CFP. Non-mydriatic fundus camera.
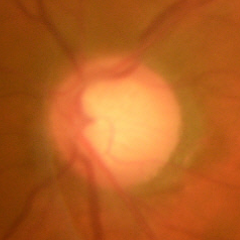 Early glaucomatous changes.